Camera: Nidek AFC-330. Disc-centered field.
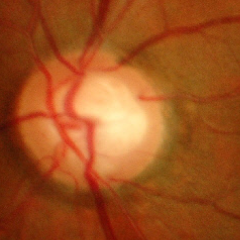

Assessment = advanced glaucomatous optic neuropathy.